Fundus photo taken with a portable handheld camera.
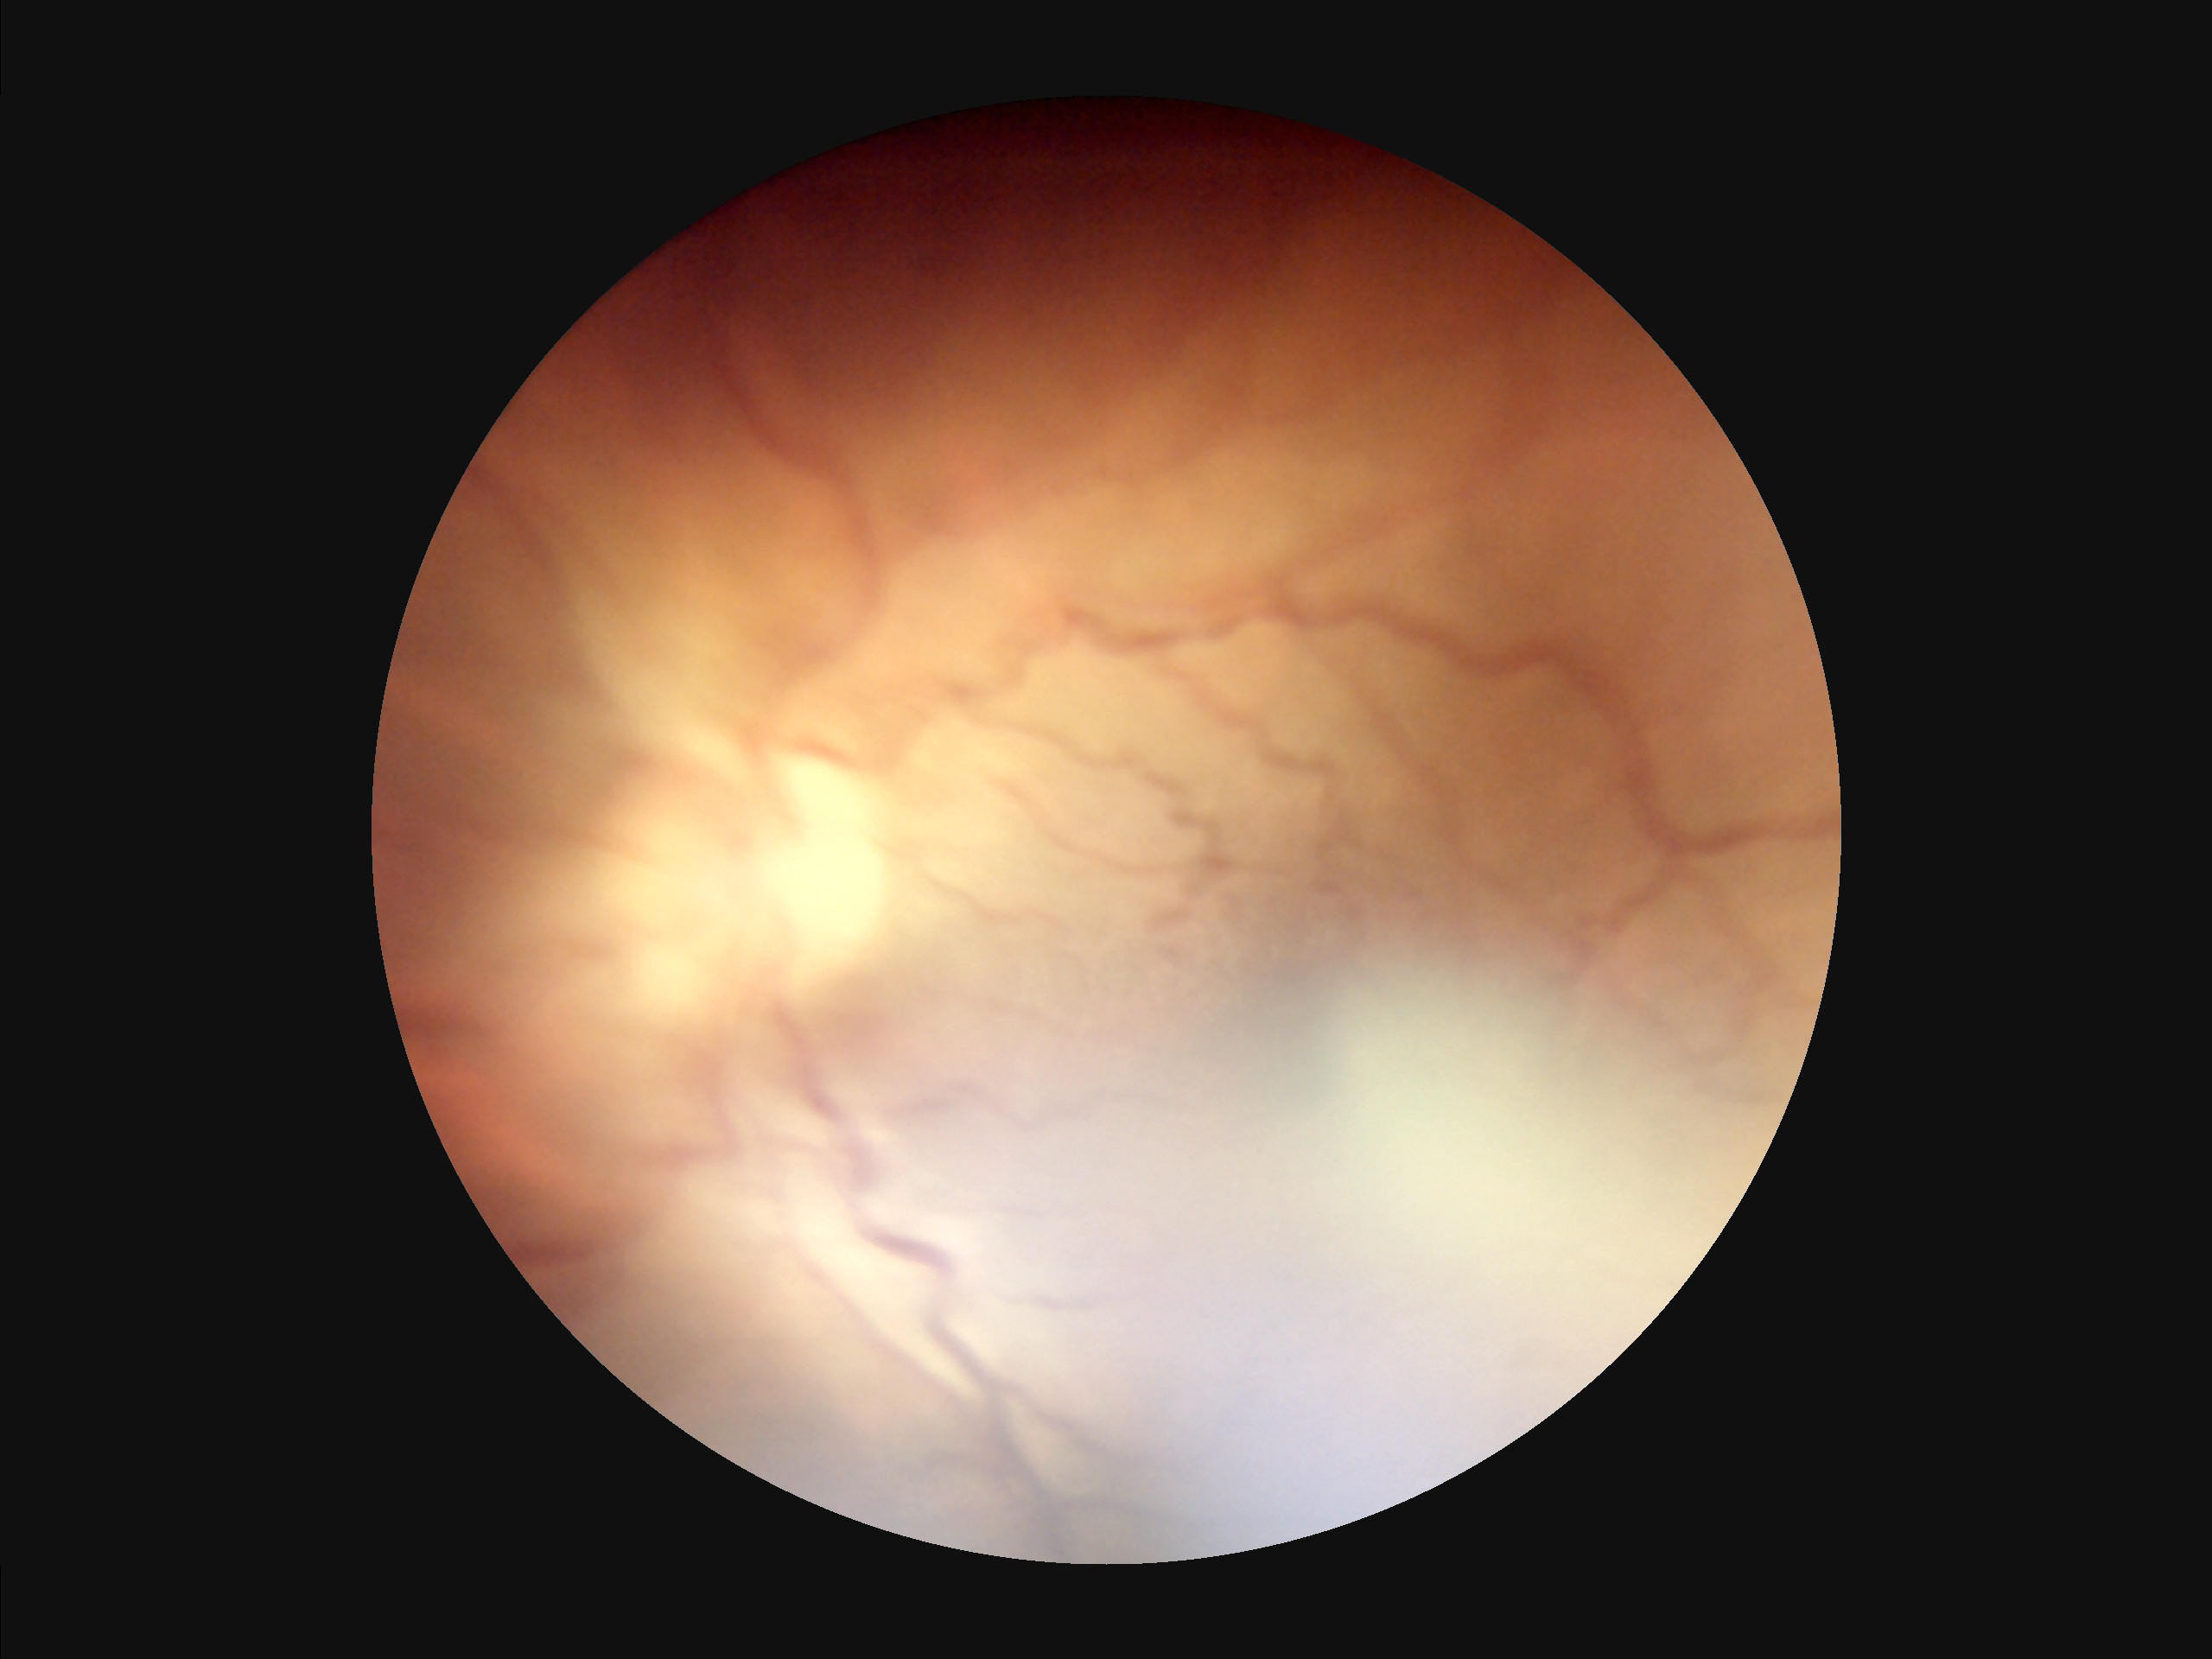

{"overall_quality": "poor and difficult to use diagnostically", "clarity": "optic disc, vessels, and background in focus", "contrast": "wide intensity range, structures distinguishable", "illumination": "even and well-balanced"}